45° field of view · CFP · 1960 by 1897 pixels
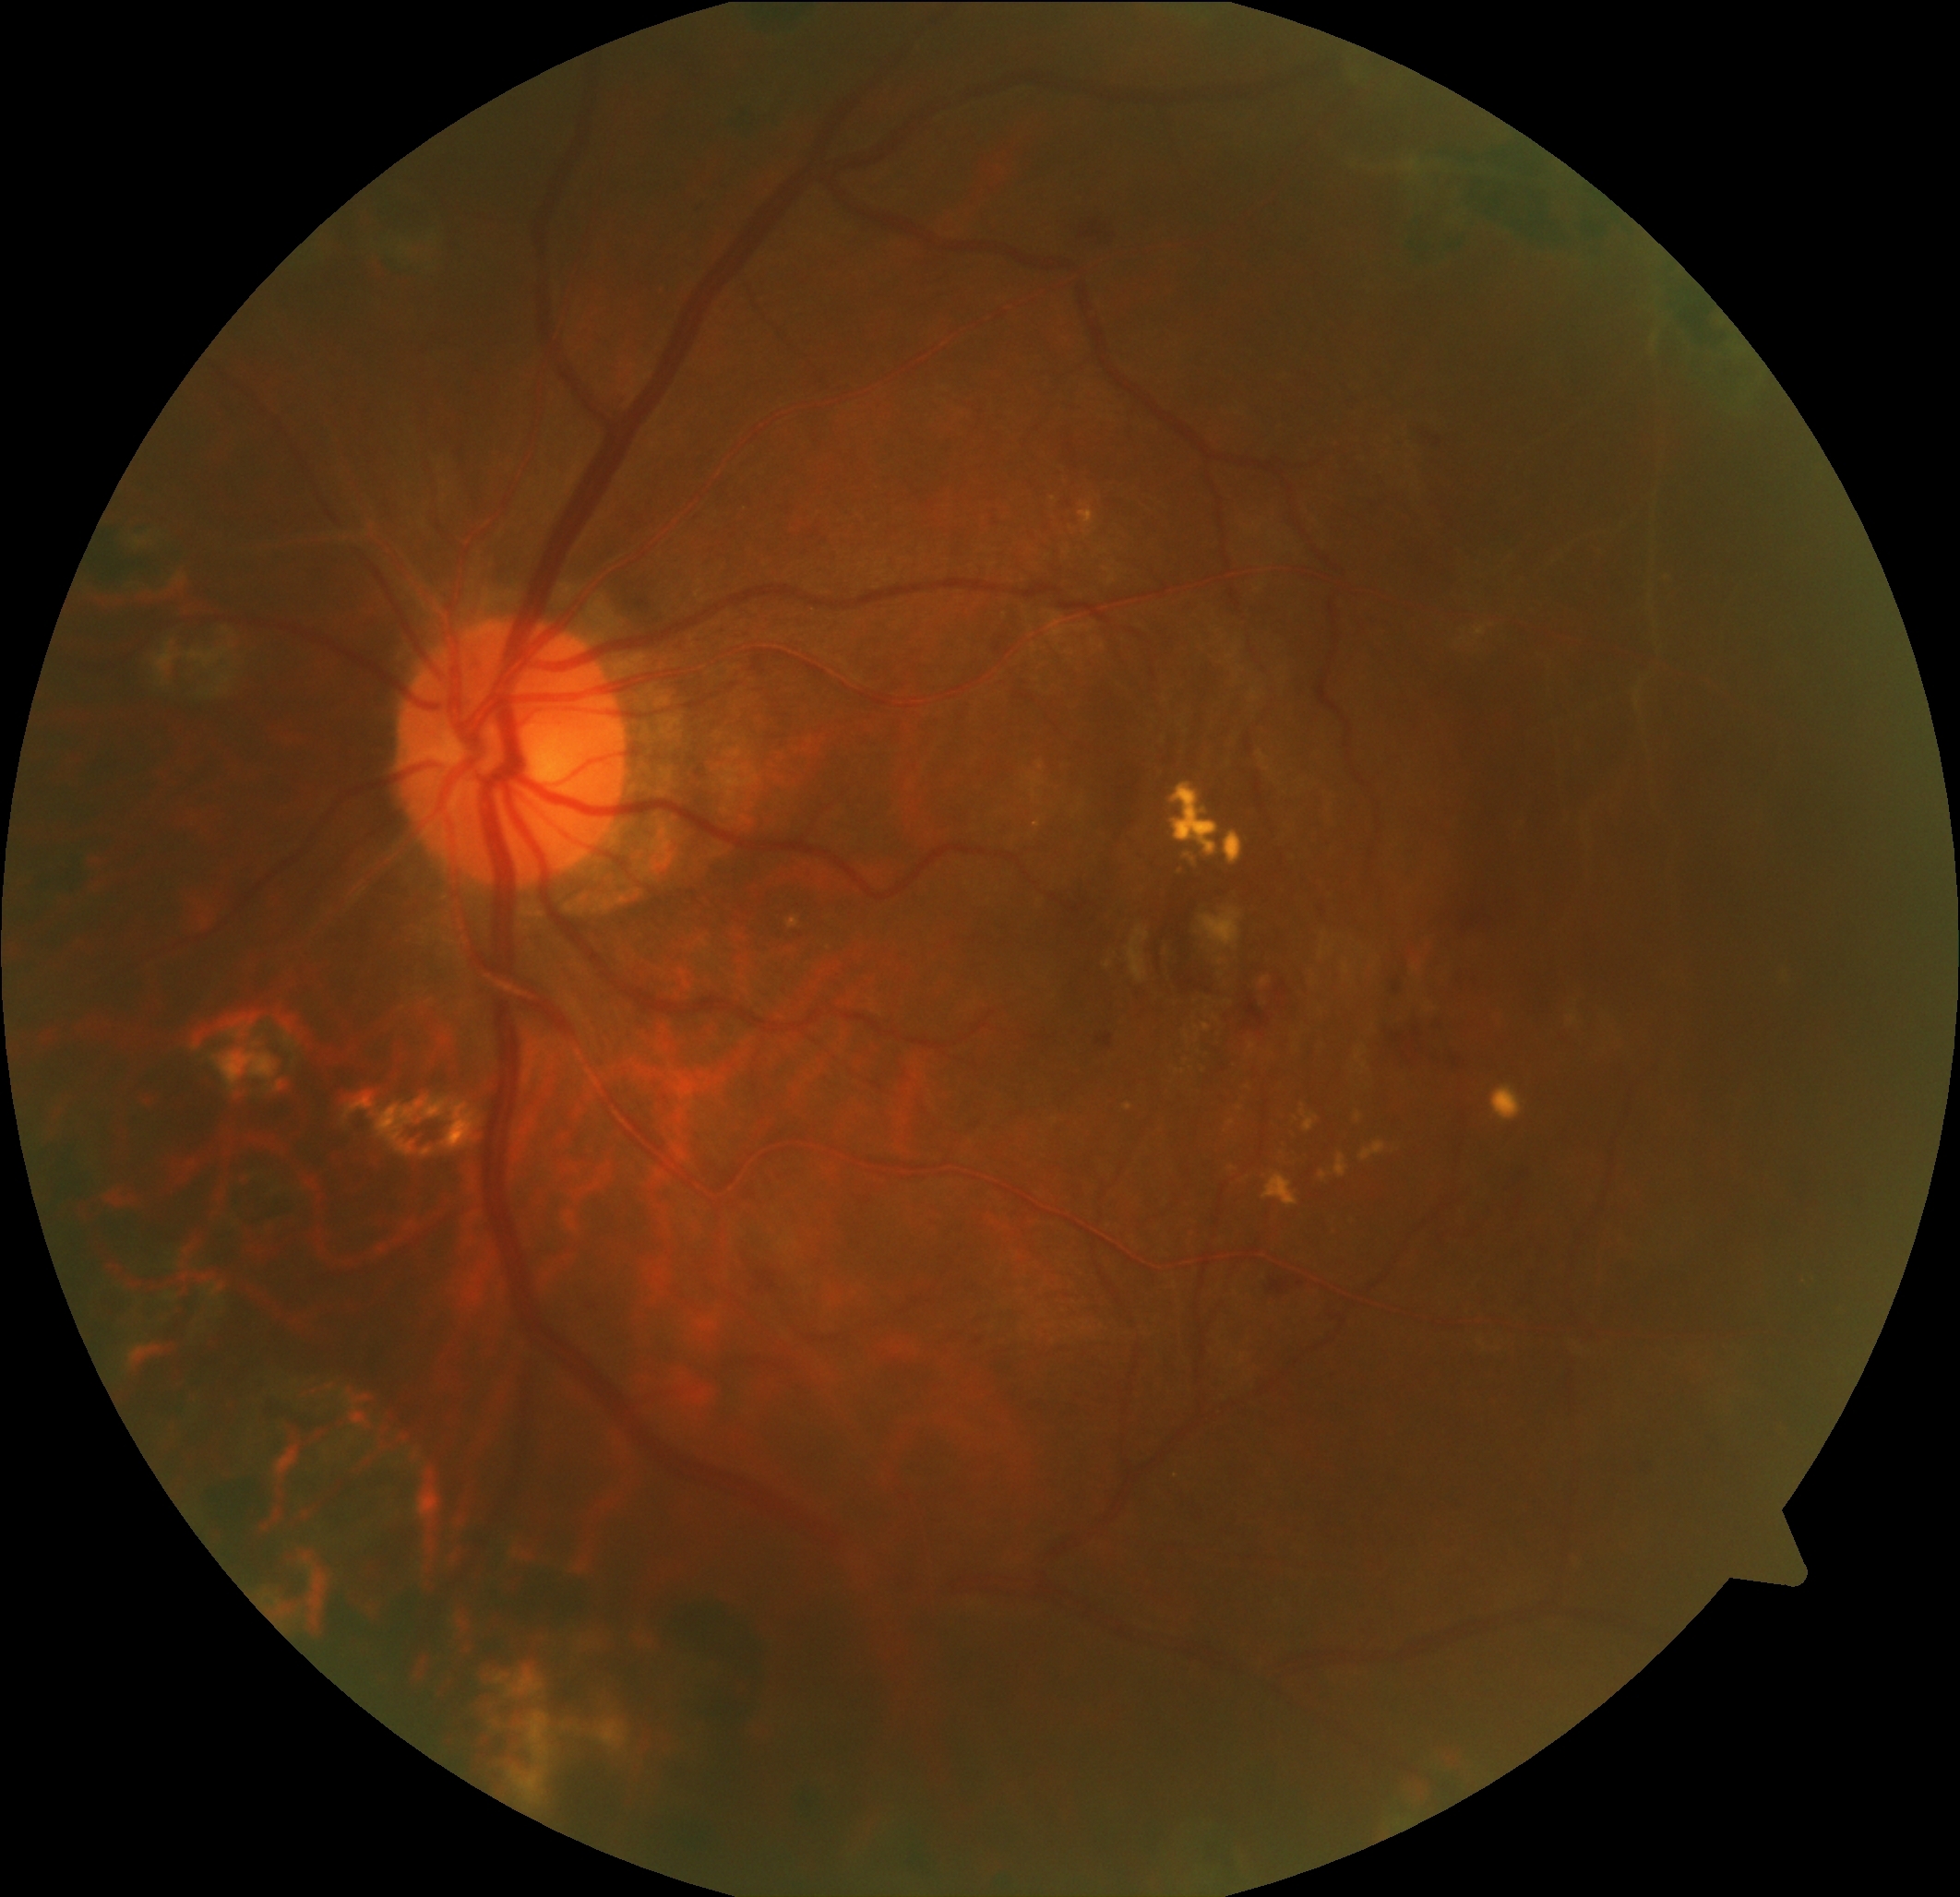

Retinopathy: grade 2 (moderate NPDR).